Wide-field contact fundus photograph of an infant: 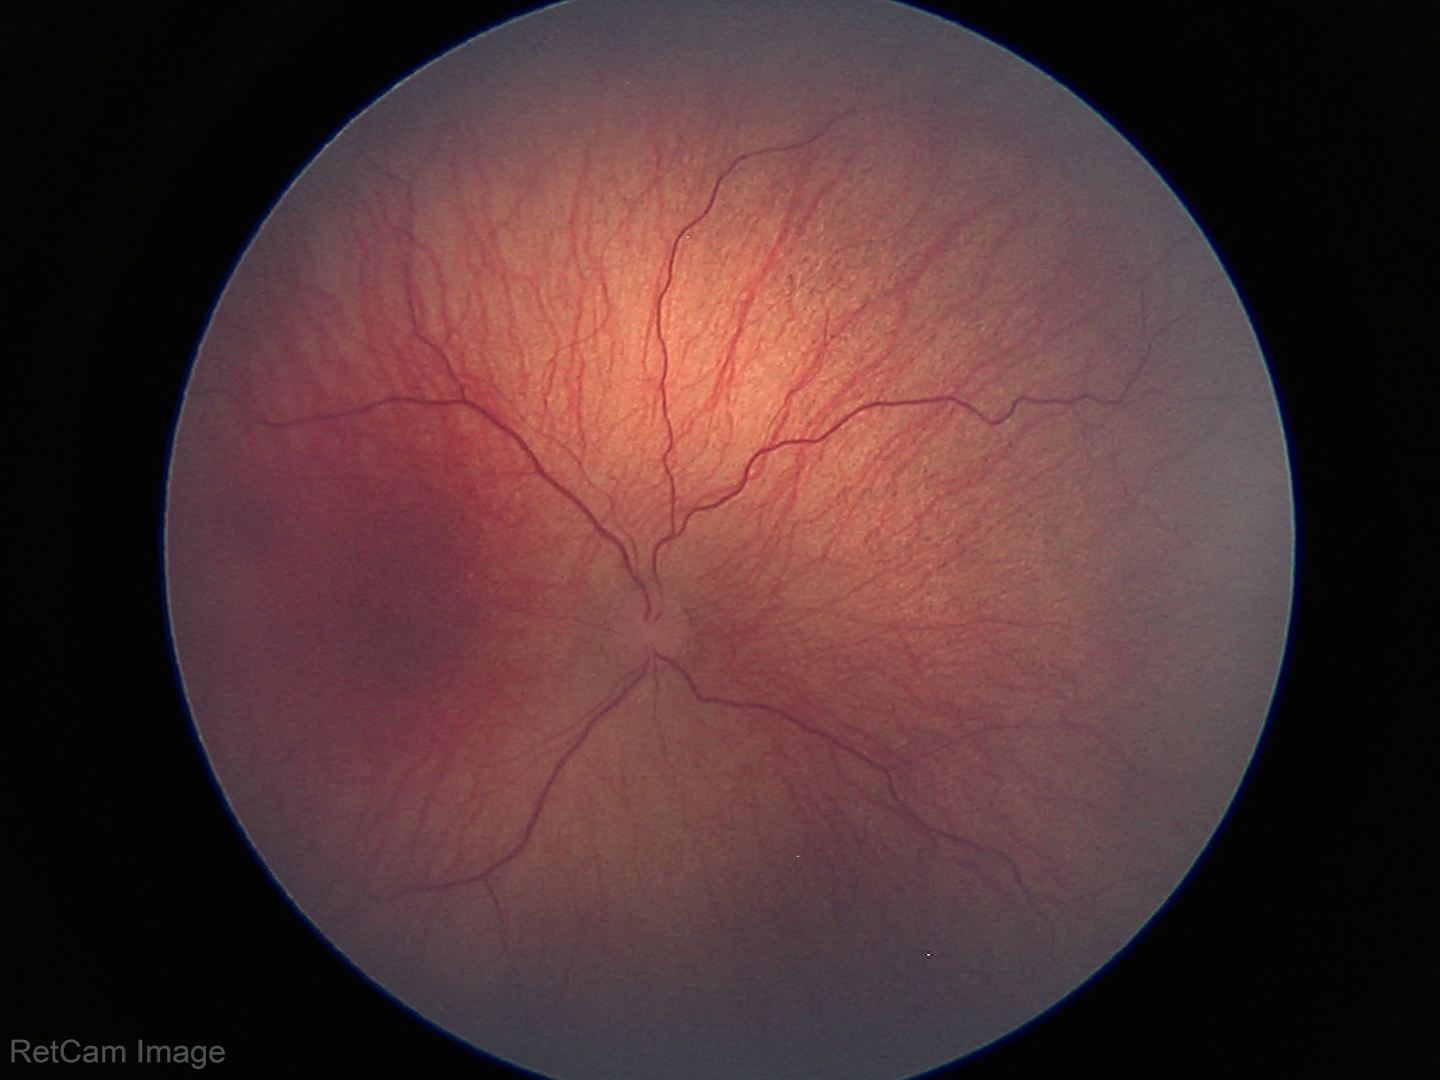
Series diagnosed as ROP stage 1.